45° field of view
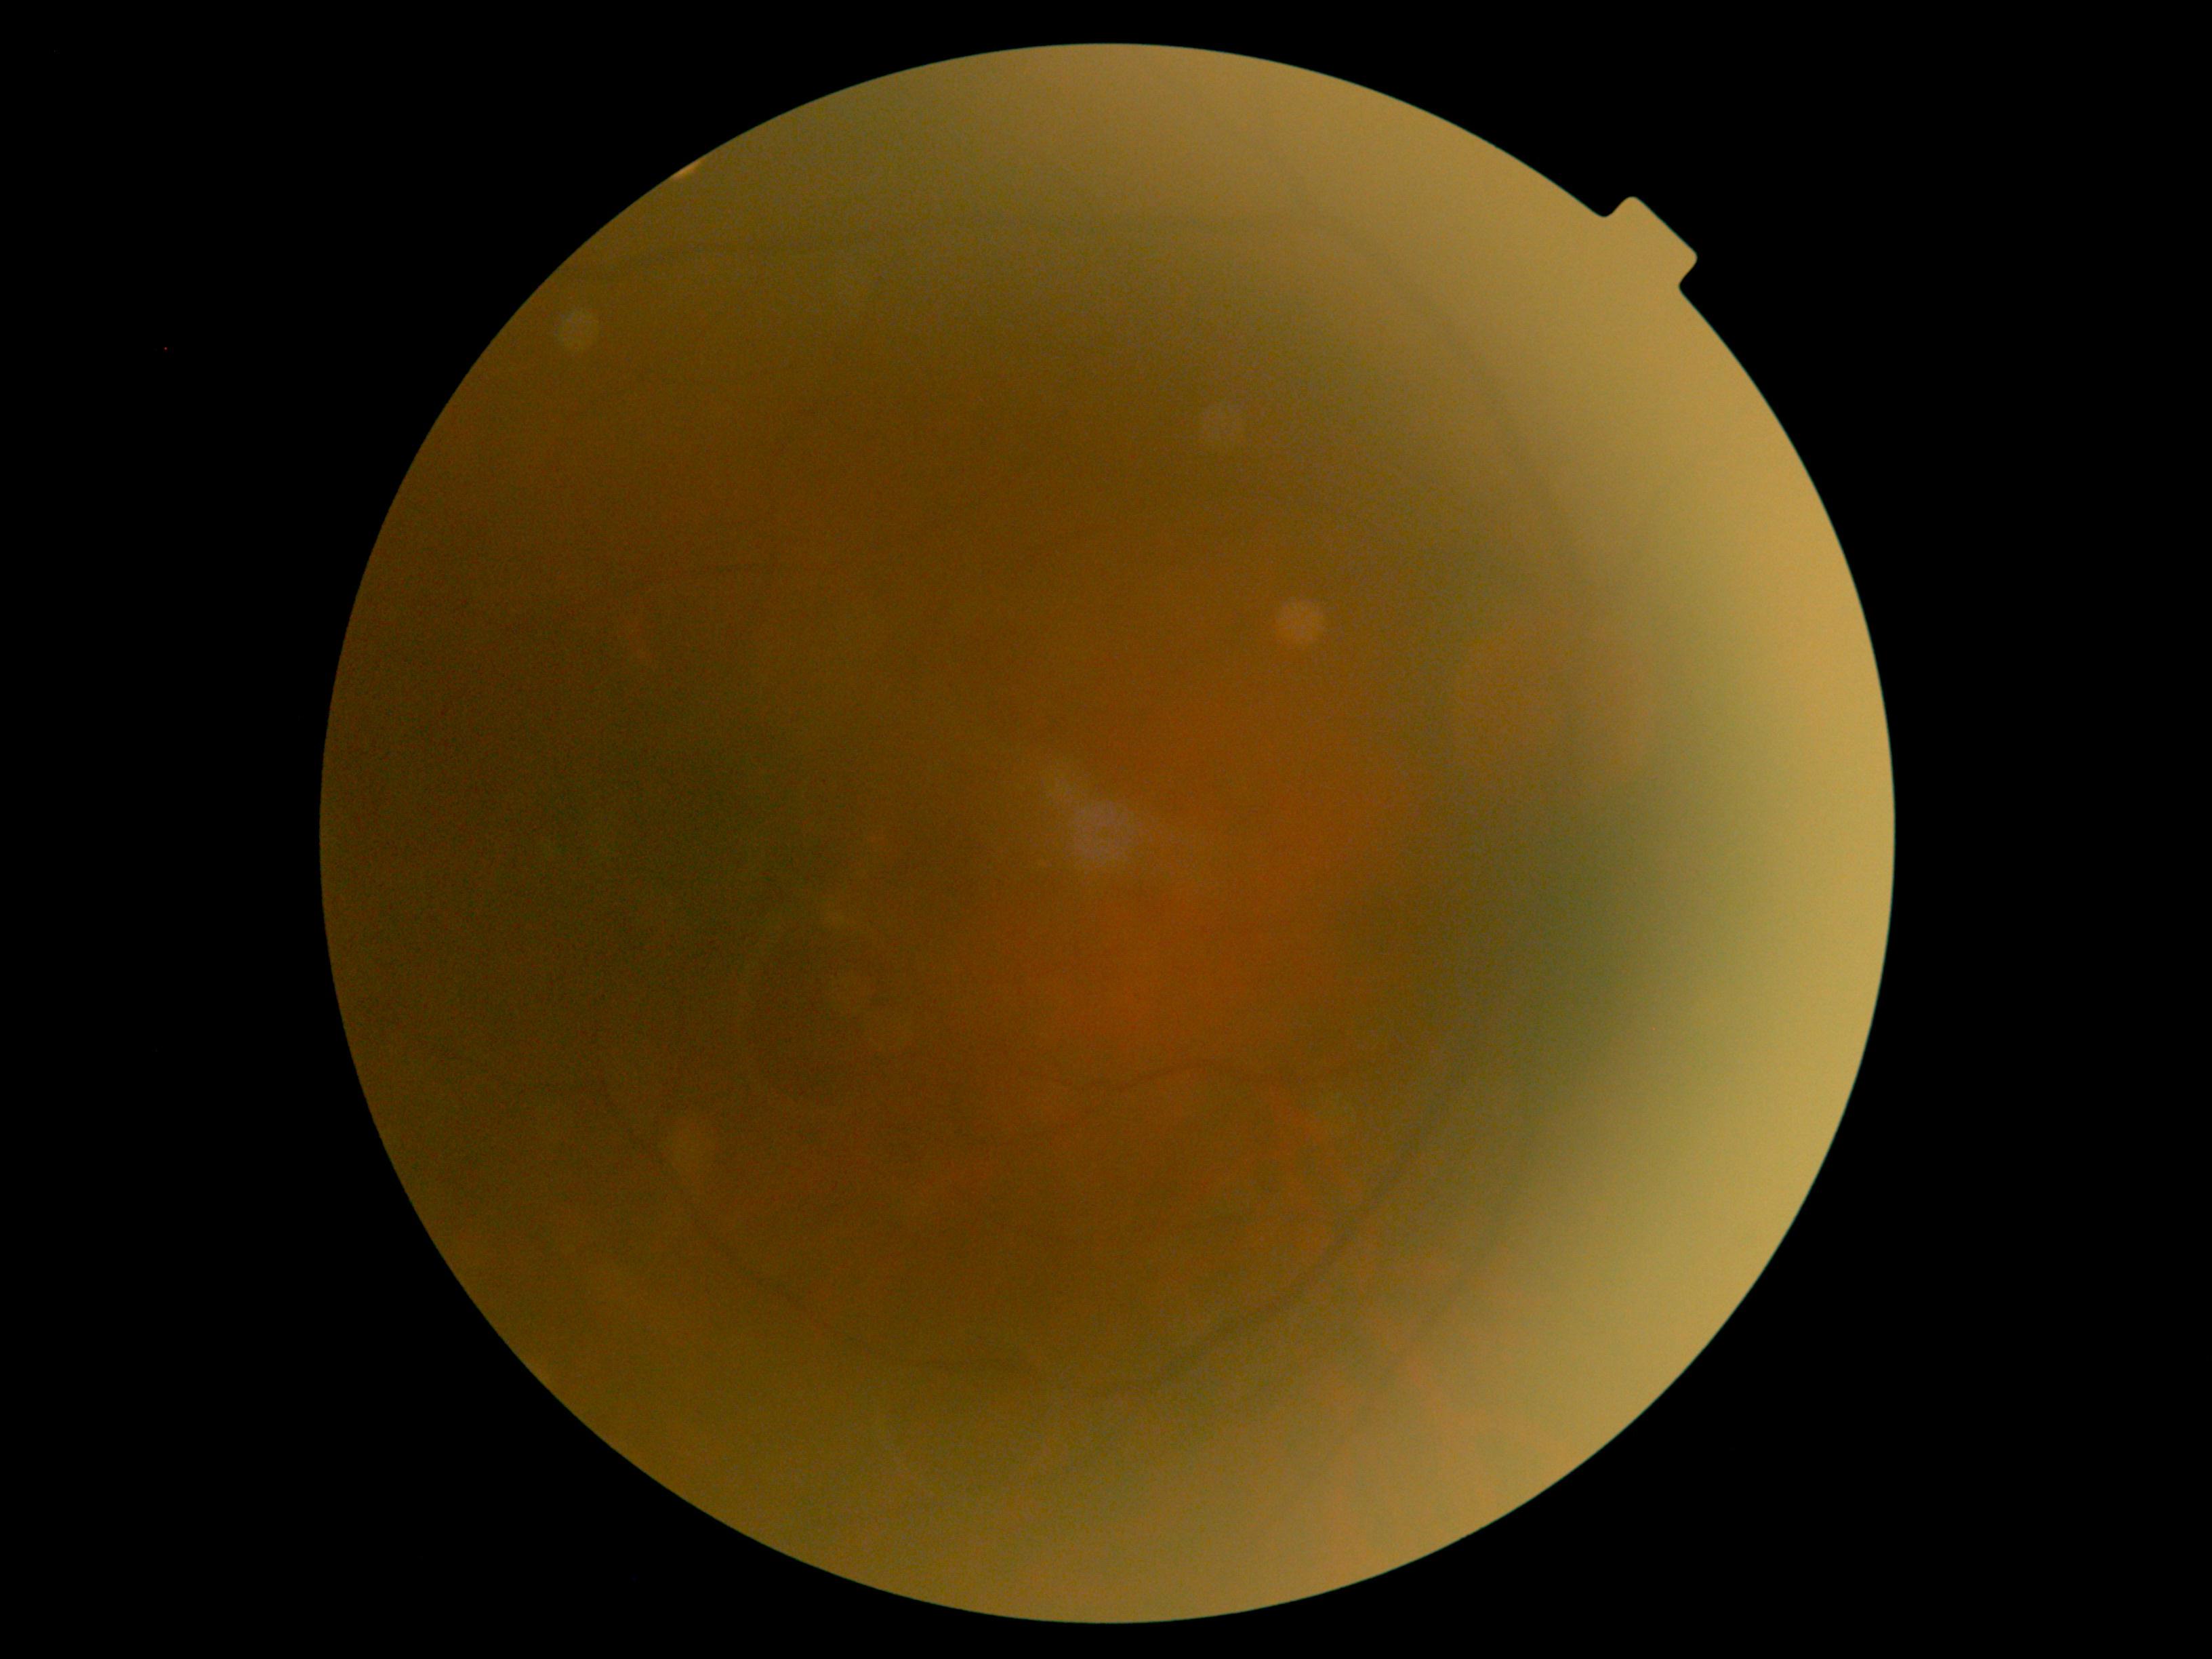

DR grade: 0 (no apparent retinopathy).